No pharmacologic dilation; modified Davis classification; 848 x 848 pixels.
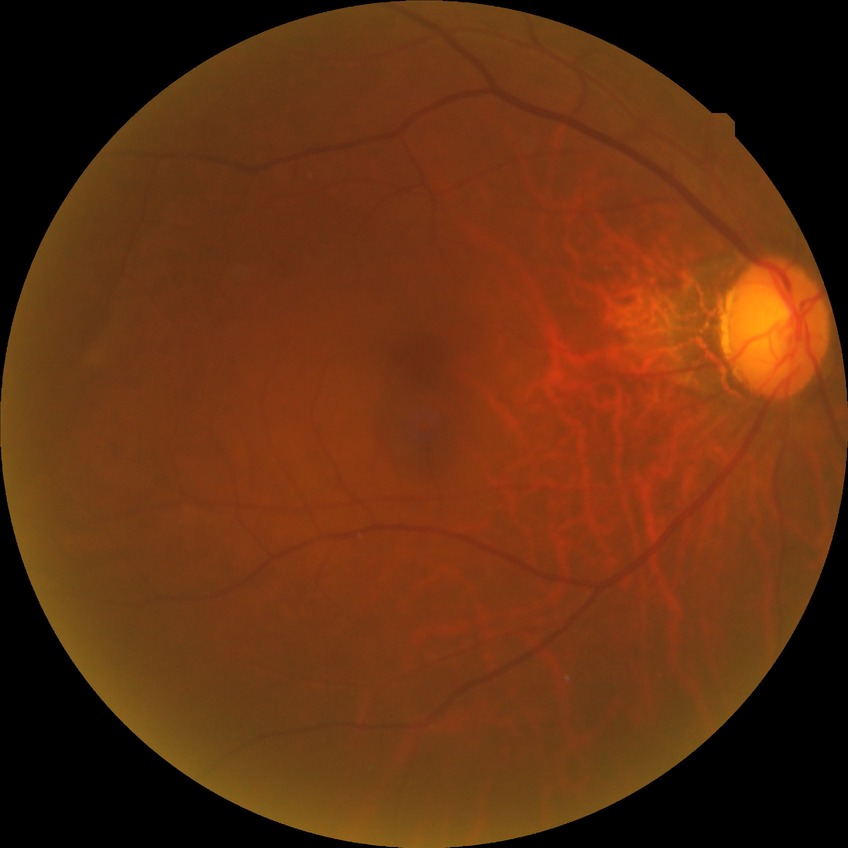 Davis grading is no diabetic retinopathy.